ONH-centered crop from a color fundus image
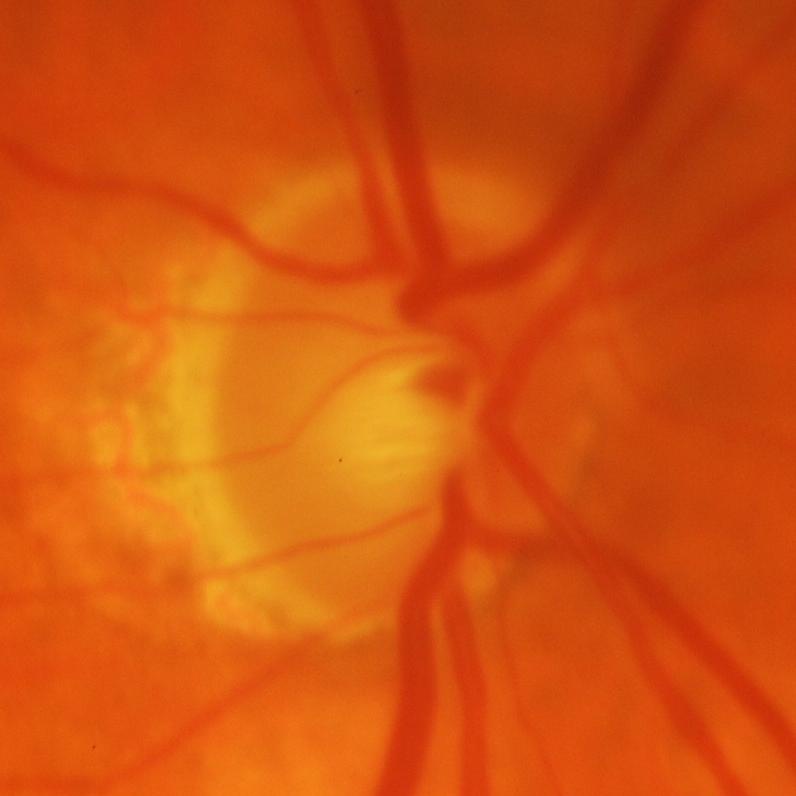
Glaucomatous changes.